640x480px. 130° field of view (Clarity RetCam 3). Infant wide-field fundus photograph: 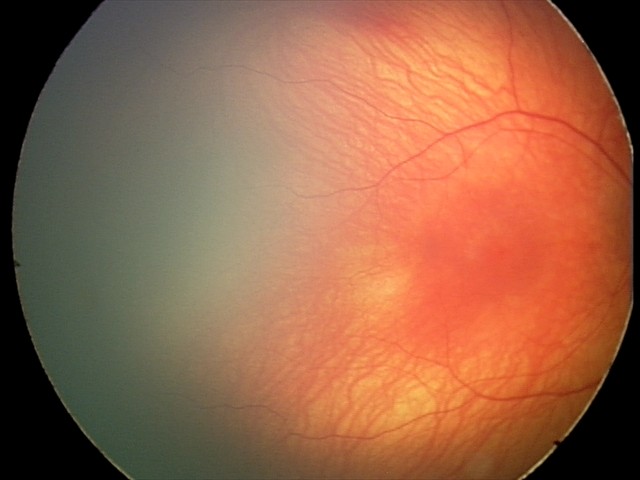

Screening diagnosis = no pathology identified